Camera: NIDEK AFC-230, modified Davis grading, 45° FOV: 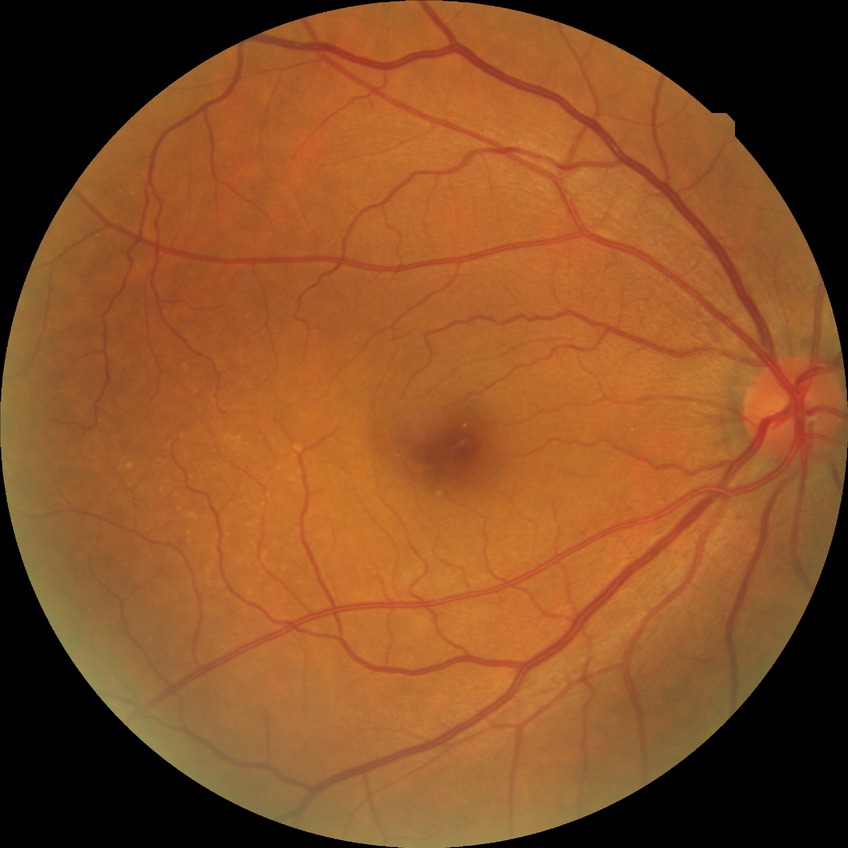
davis_grade: NDR (no diabetic retinopathy)